Image size 1440x1080; pediatric wide-field fundus photograph:
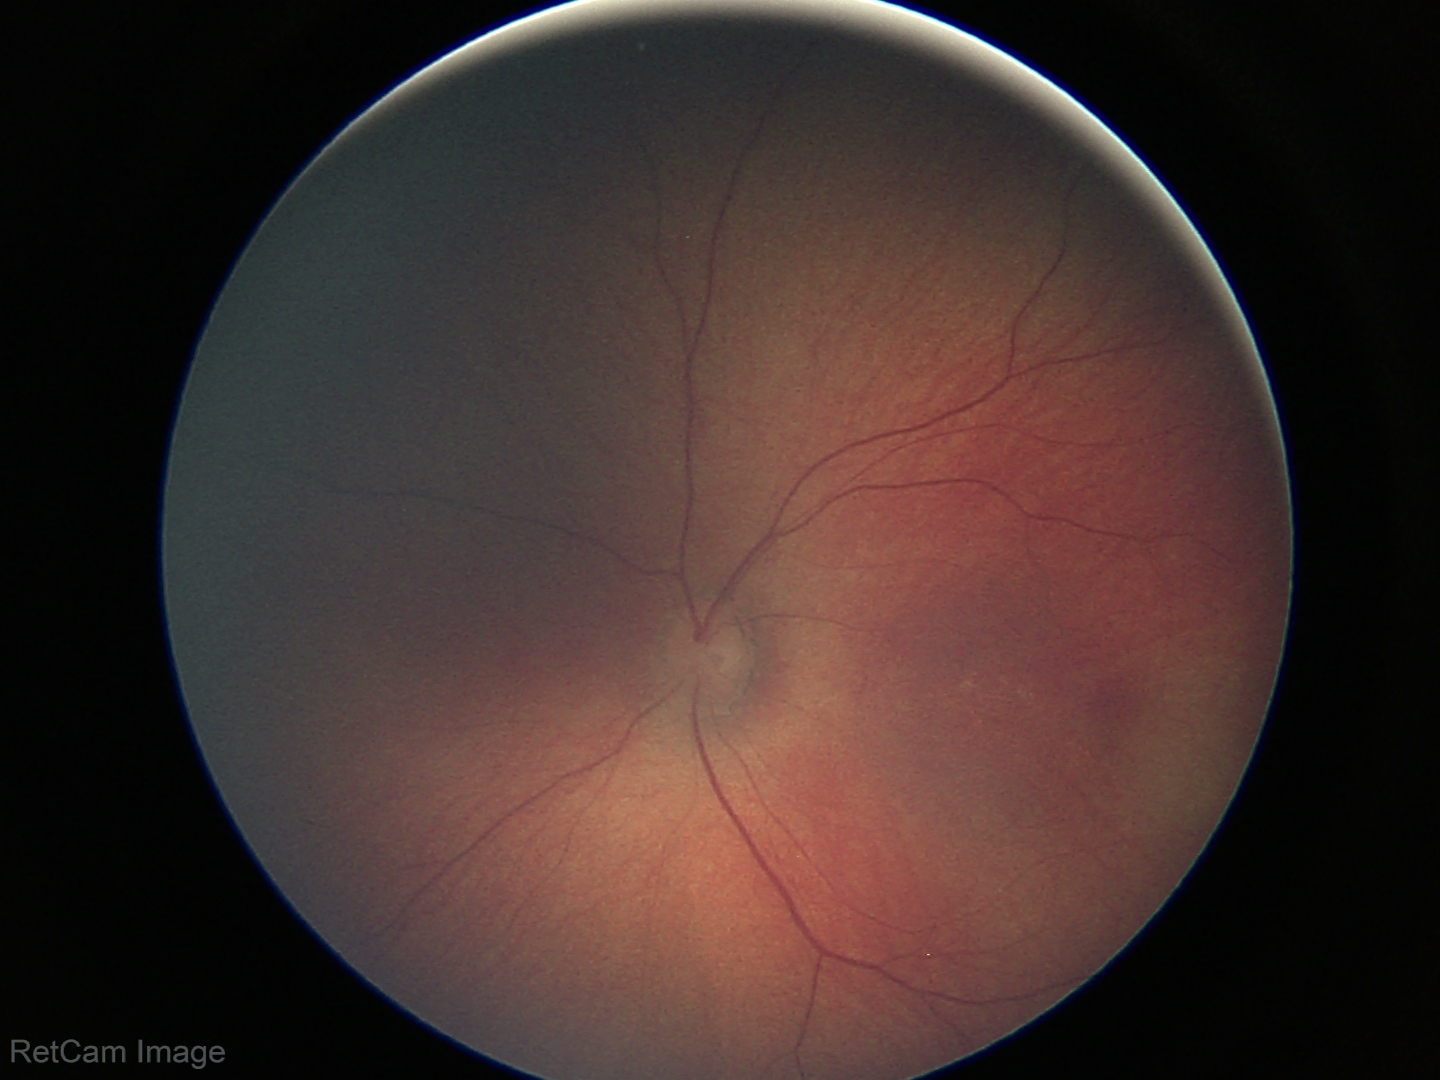 Screening diagnosis: no pathology identified.